Without pupil dilation. 848 by 848 pixels. CFP. 45° FOV:
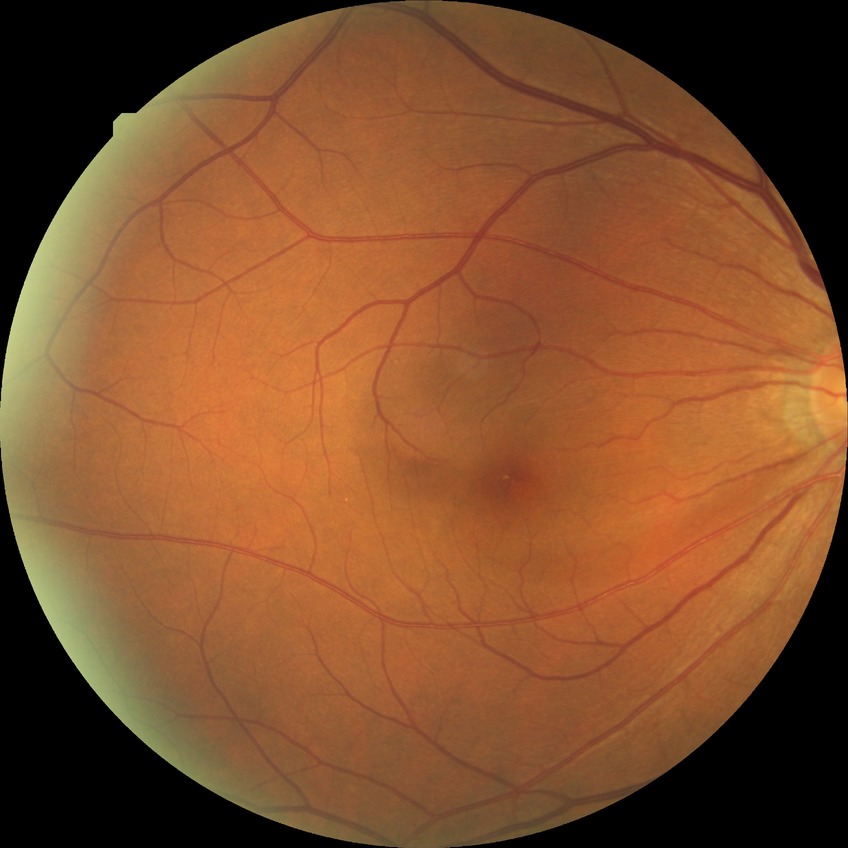
Diabetic retinopathy severity: no diabetic retinopathy.